Phoenix ICON wide-field infant fundus image
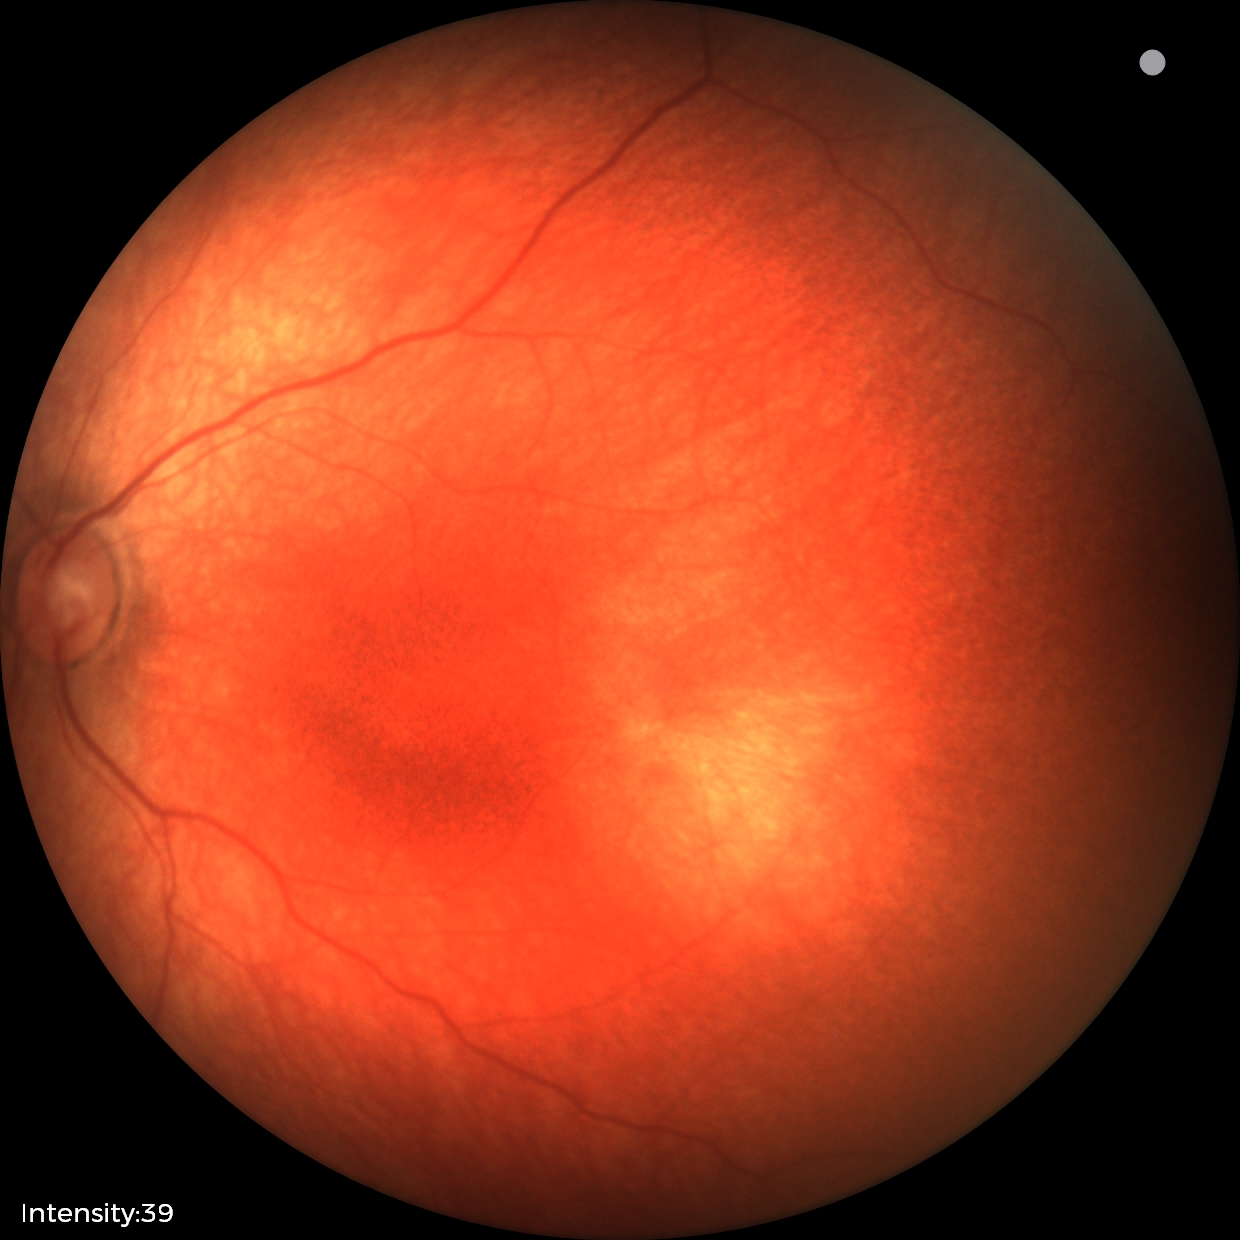 No retinal pathology identified on screening.